Posterior pole color fundus photograph — 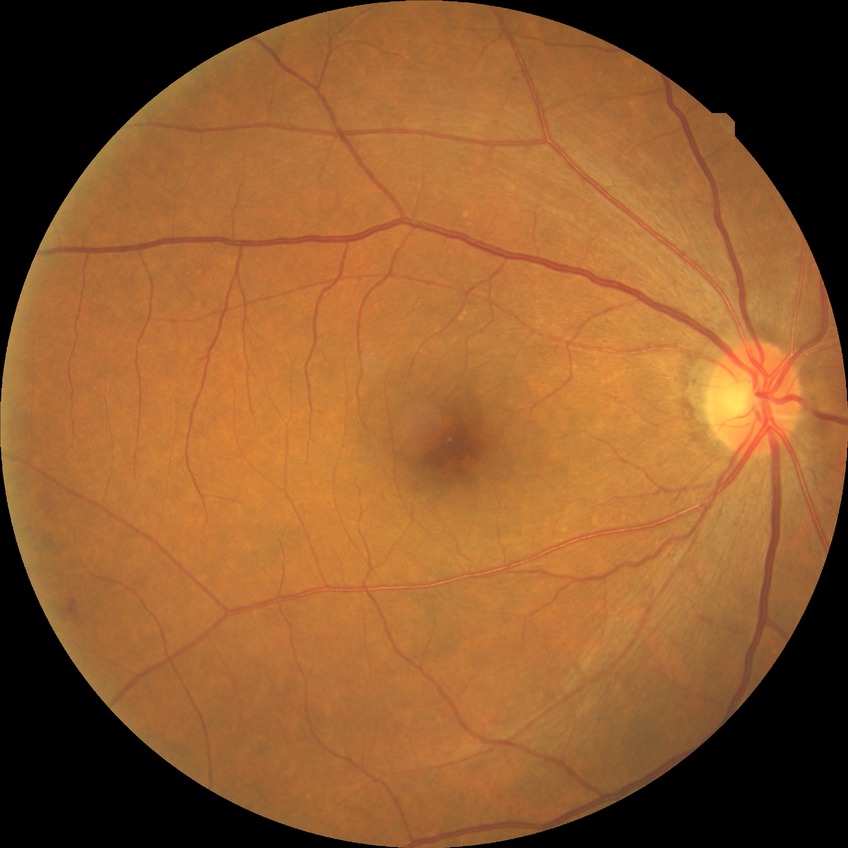
diabetic retinopathy severity = simple diabetic retinopathy | DR class = non-proliferative diabetic retinopathy.